Posterior pole photograph: 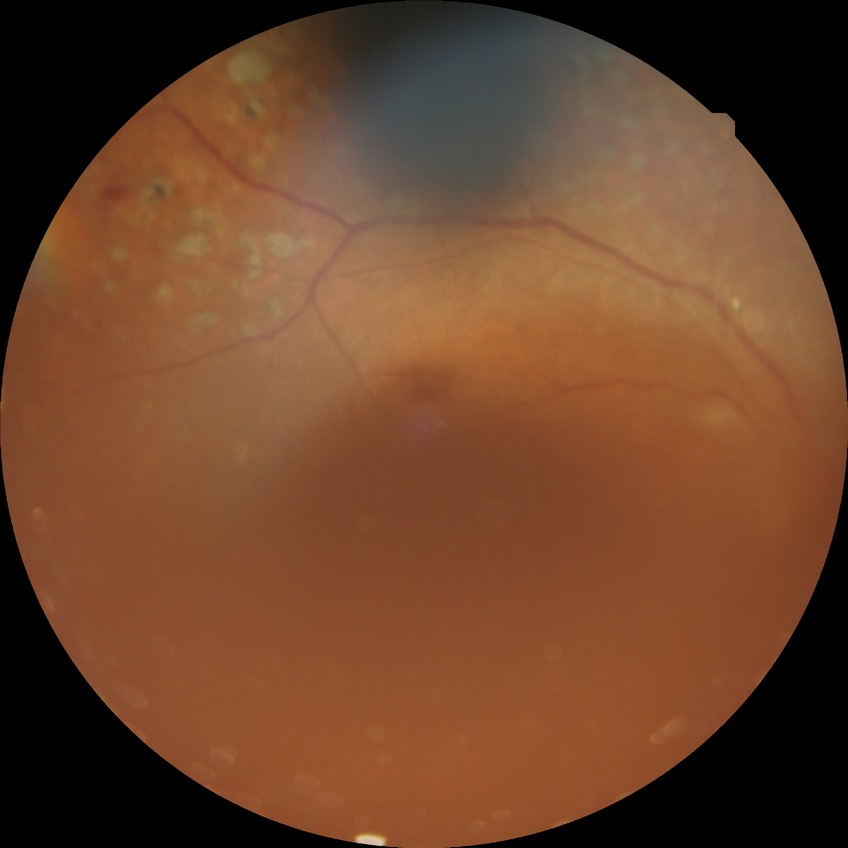 DR stage: PDR.